Infant wide-field fundus photograph; captured with the Clarity RetCam 3 (130° field of view)
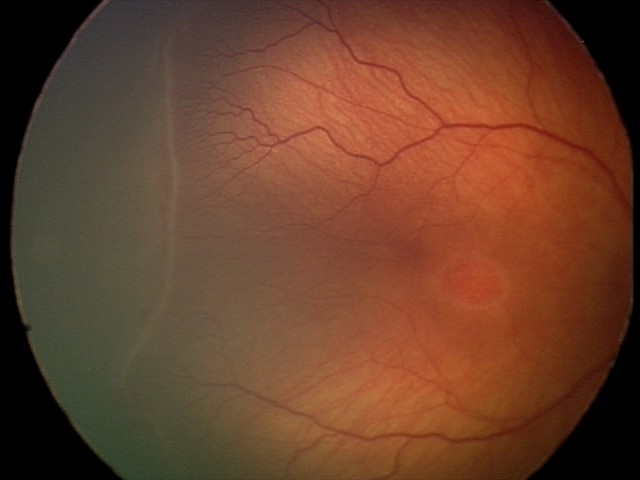
Impression = retinopathy of prematurity (ROP) stage 2, plus form = absent.